Retinal fundus photograph. 45° field of view
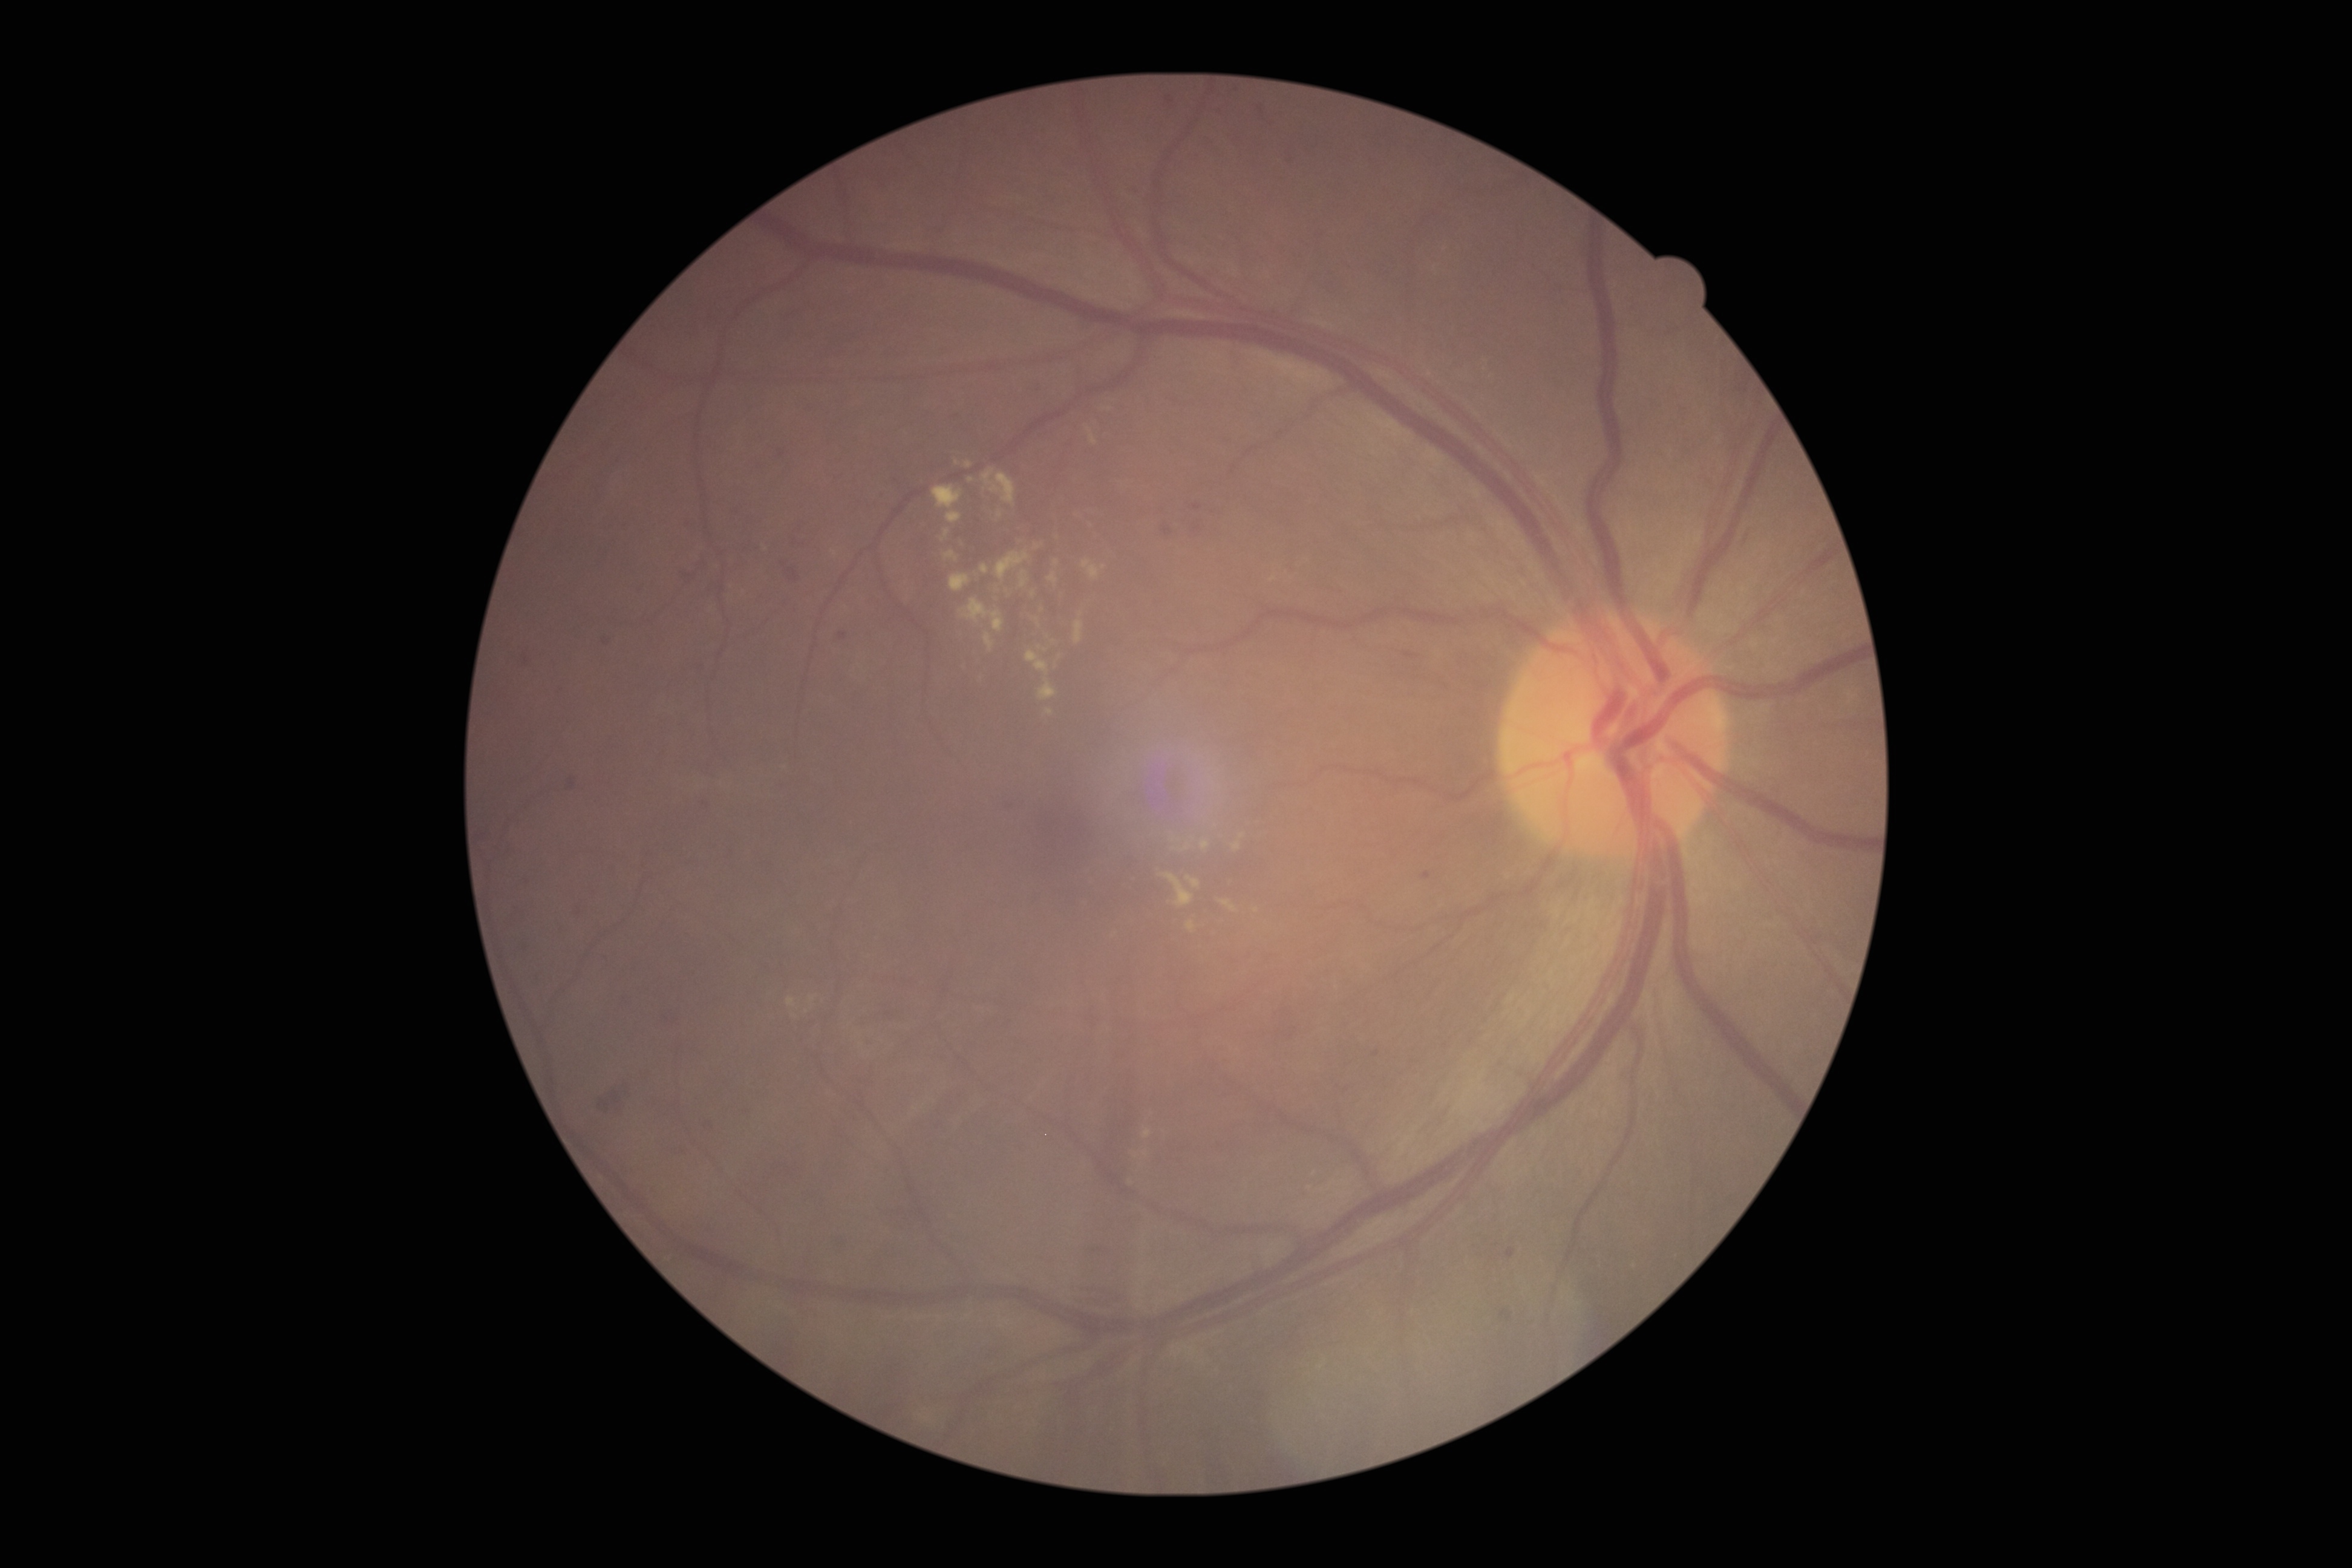
Retinopathy: 2
Representative lesions:
microaneurysms (more not shown): BBox(1288, 155, 1295, 164), BBox(522, 650, 531, 667), BBox(567, 777, 577, 793), BBox(662, 1016, 679, 1027), BBox(702, 802, 712, 811), BBox(838, 1242, 846, 1248), BBox(1420, 872, 1433, 880), BBox(1163, 95, 1177, 111), BBox(602, 638, 612, 647), BBox(1190, 520, 1204, 538), BBox(743, 1110, 751, 1115), BBox(838, 632, 848, 643), BBox(884, 1011, 895, 1023)
Small microaneurysms near x=732, y=853, x=771, y=865, x=528, y=883
hard exudates (more not shown): BBox(1048, 573, 1058, 585), BBox(967, 479, 975, 483), BBox(1181, 844, 1190, 852), BBox(982, 469, 1017, 508), BBox(1039, 678, 1057, 701), BBox(787, 998, 797, 1008), BBox(984, 635, 994, 653), BBox(1220, 901, 1237, 913), BBox(1233, 843, 1241, 851), BBox(933, 485, 964, 510)
Small hard exudates near x=928, y=1419, x=1039, y=648, x=1043, y=610, x=1056, y=563